Captured with pupil dilation. Color fundus photograph centered on the optic disc
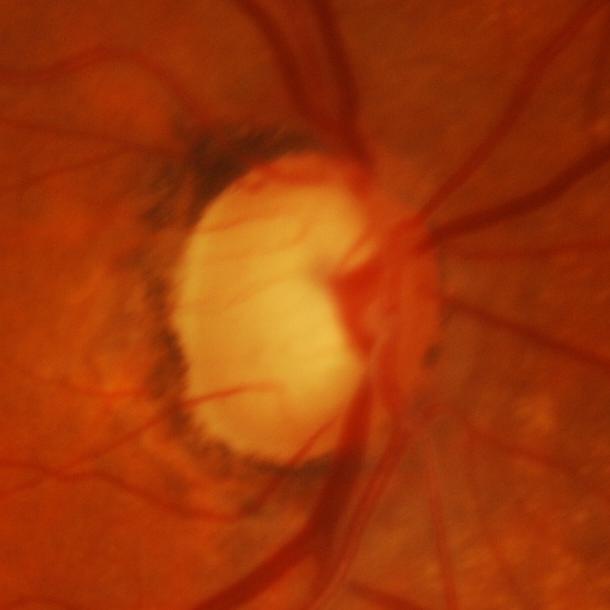
Glaucomatous damage to the optic nerve.